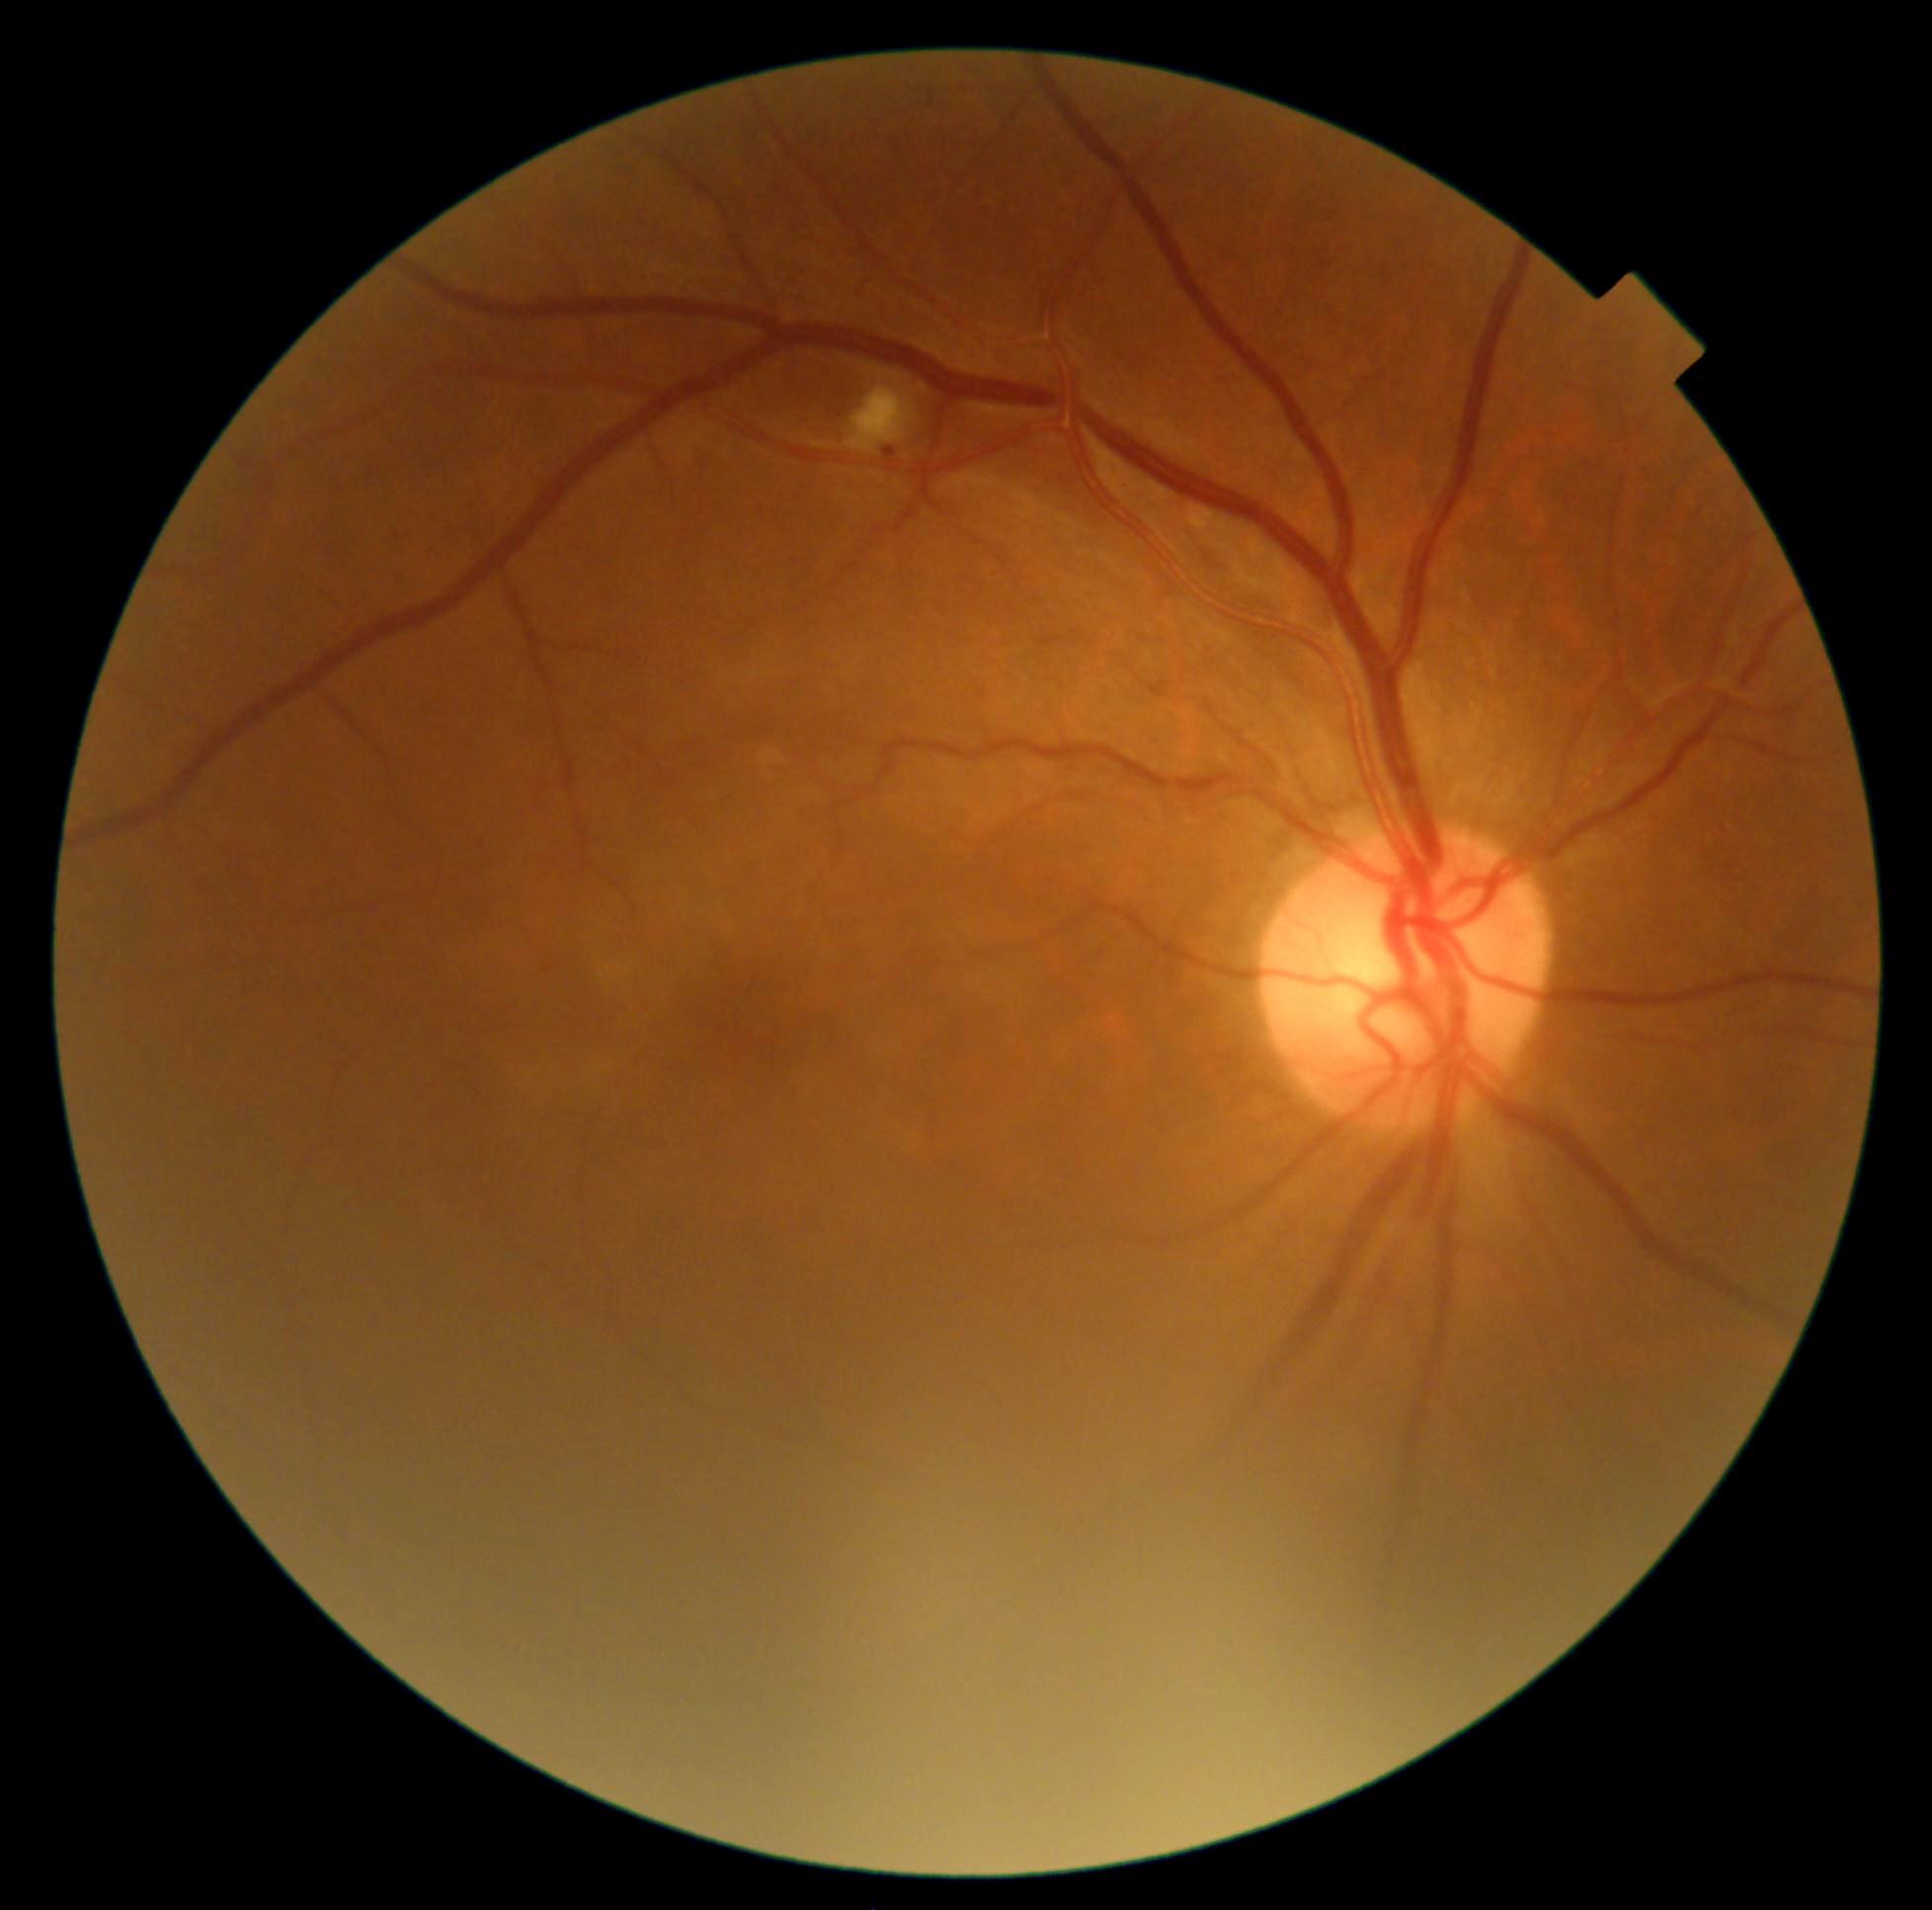
diabetic retinopathy (DR)=grade 2 (moderate NPDR) — more than just microaneurysms but less than severe NPDR.